Wide-field fundus image from infant ROP screening: 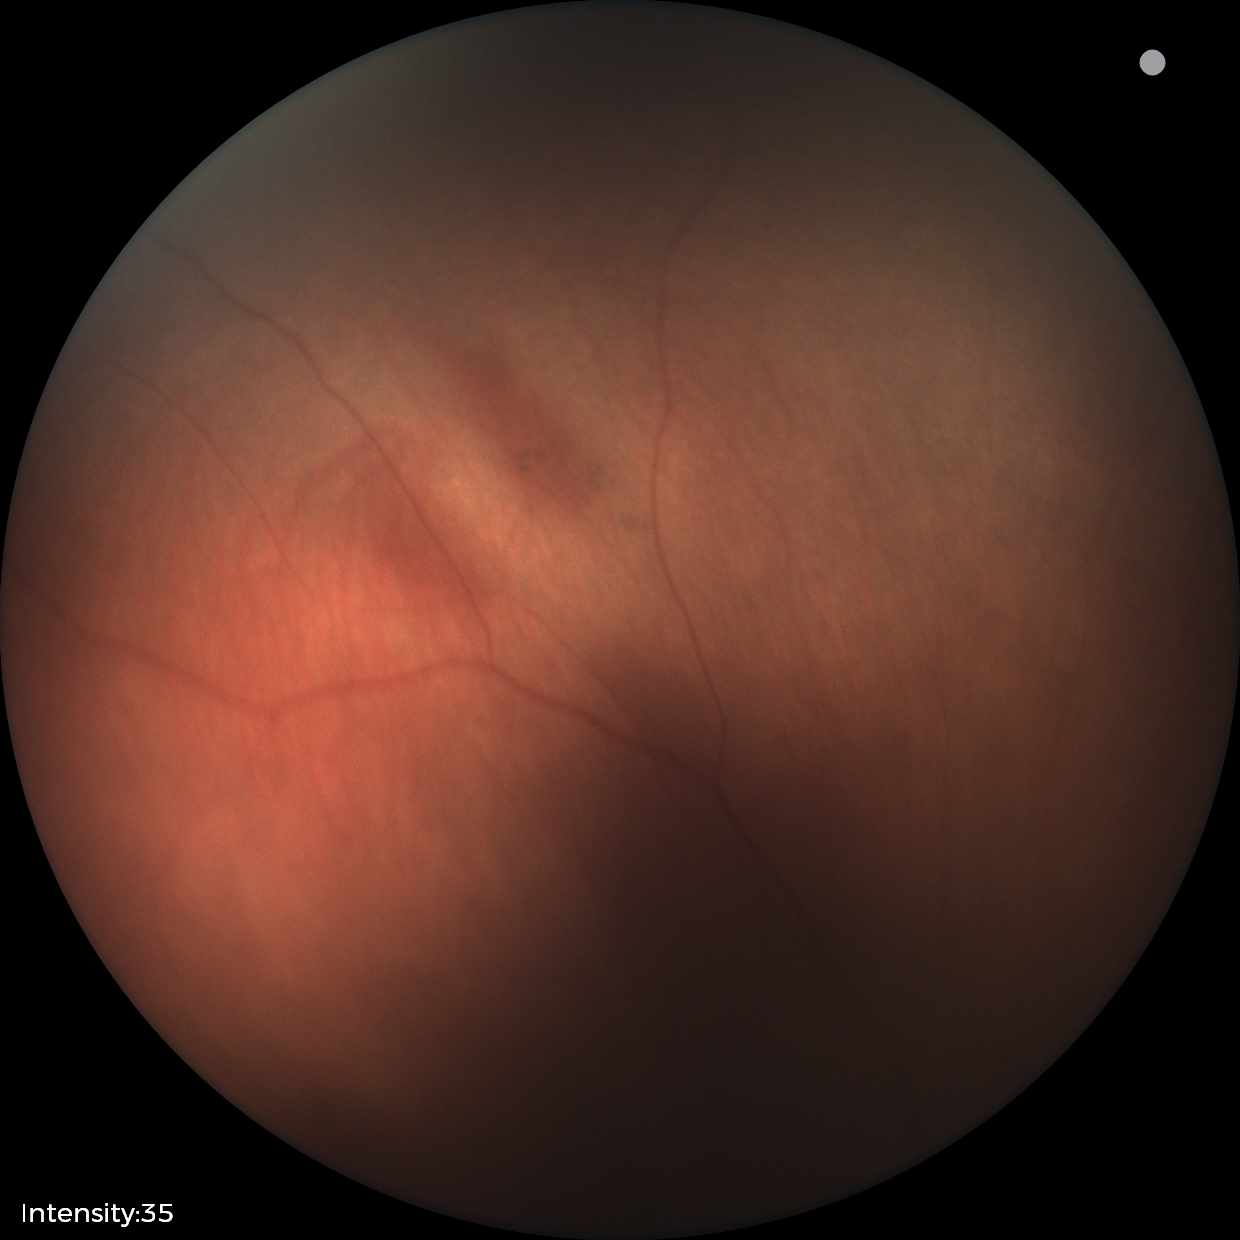

Assessment: physiological appearance with no retinal pathology.